45-degree field of view, fundus photo:
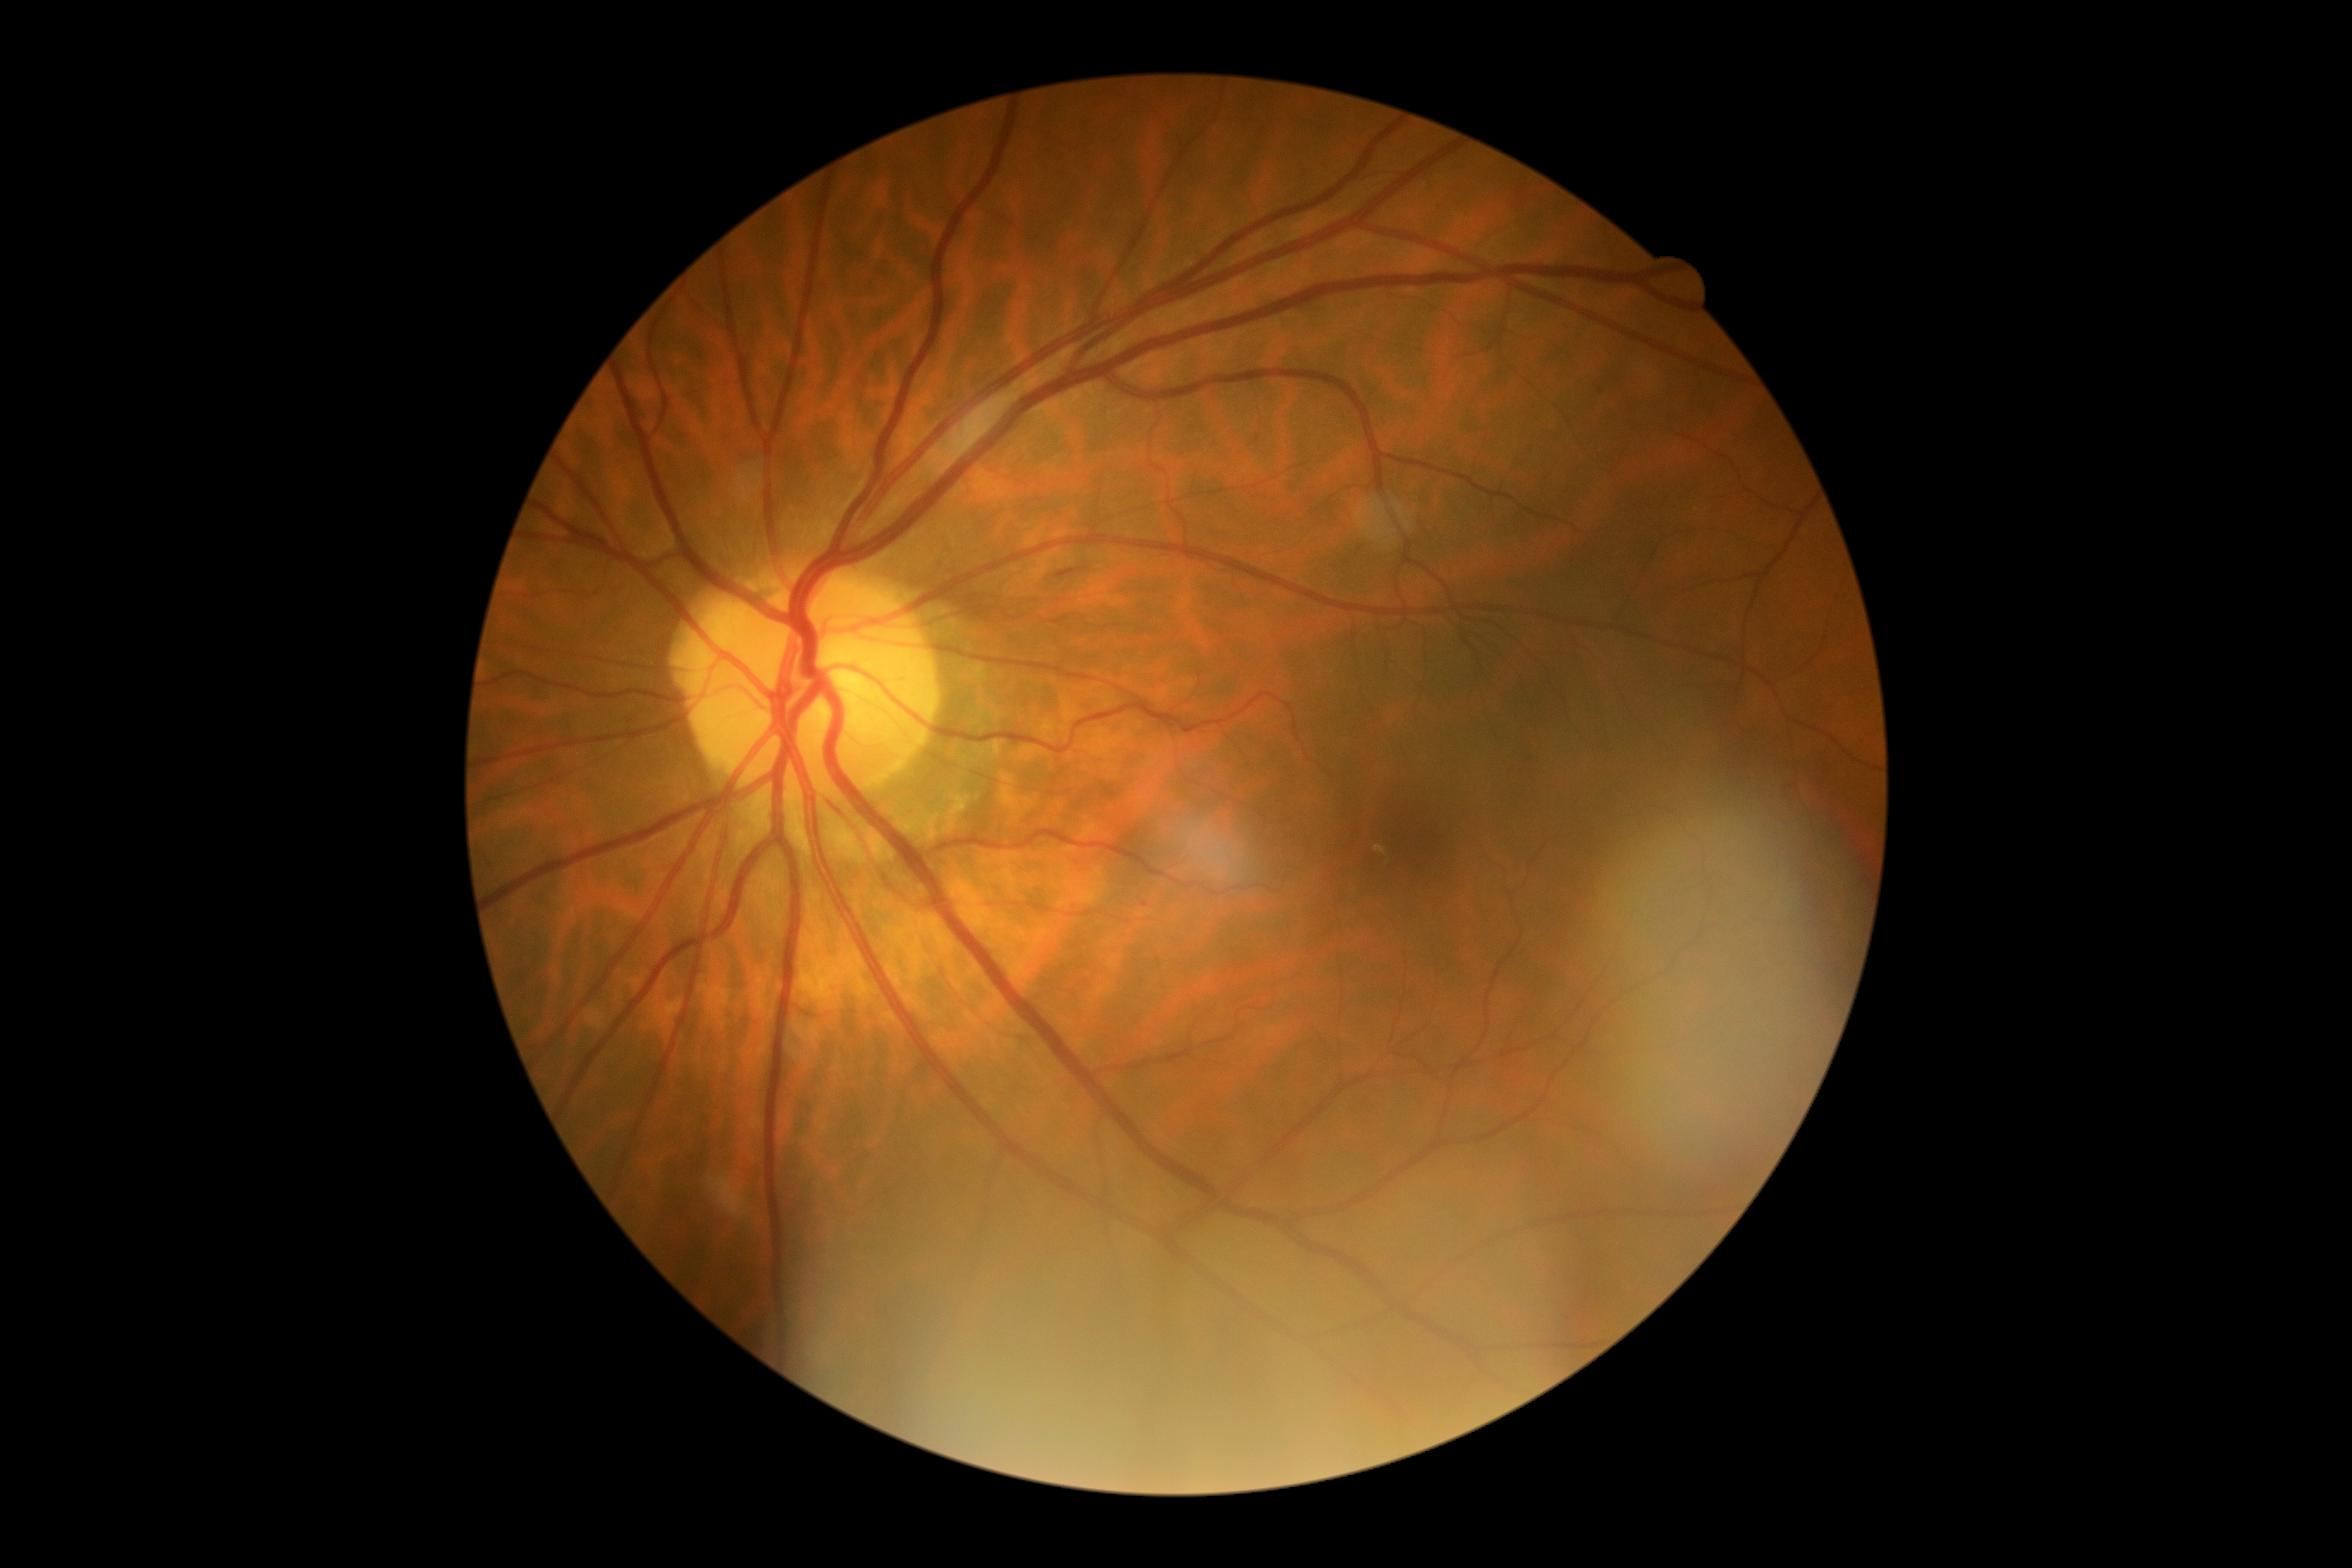
Diabetic retinopathy grade: moderate non-proliferative diabetic retinopathy (2).